FOV: 45 degrees. Color fundus photograph
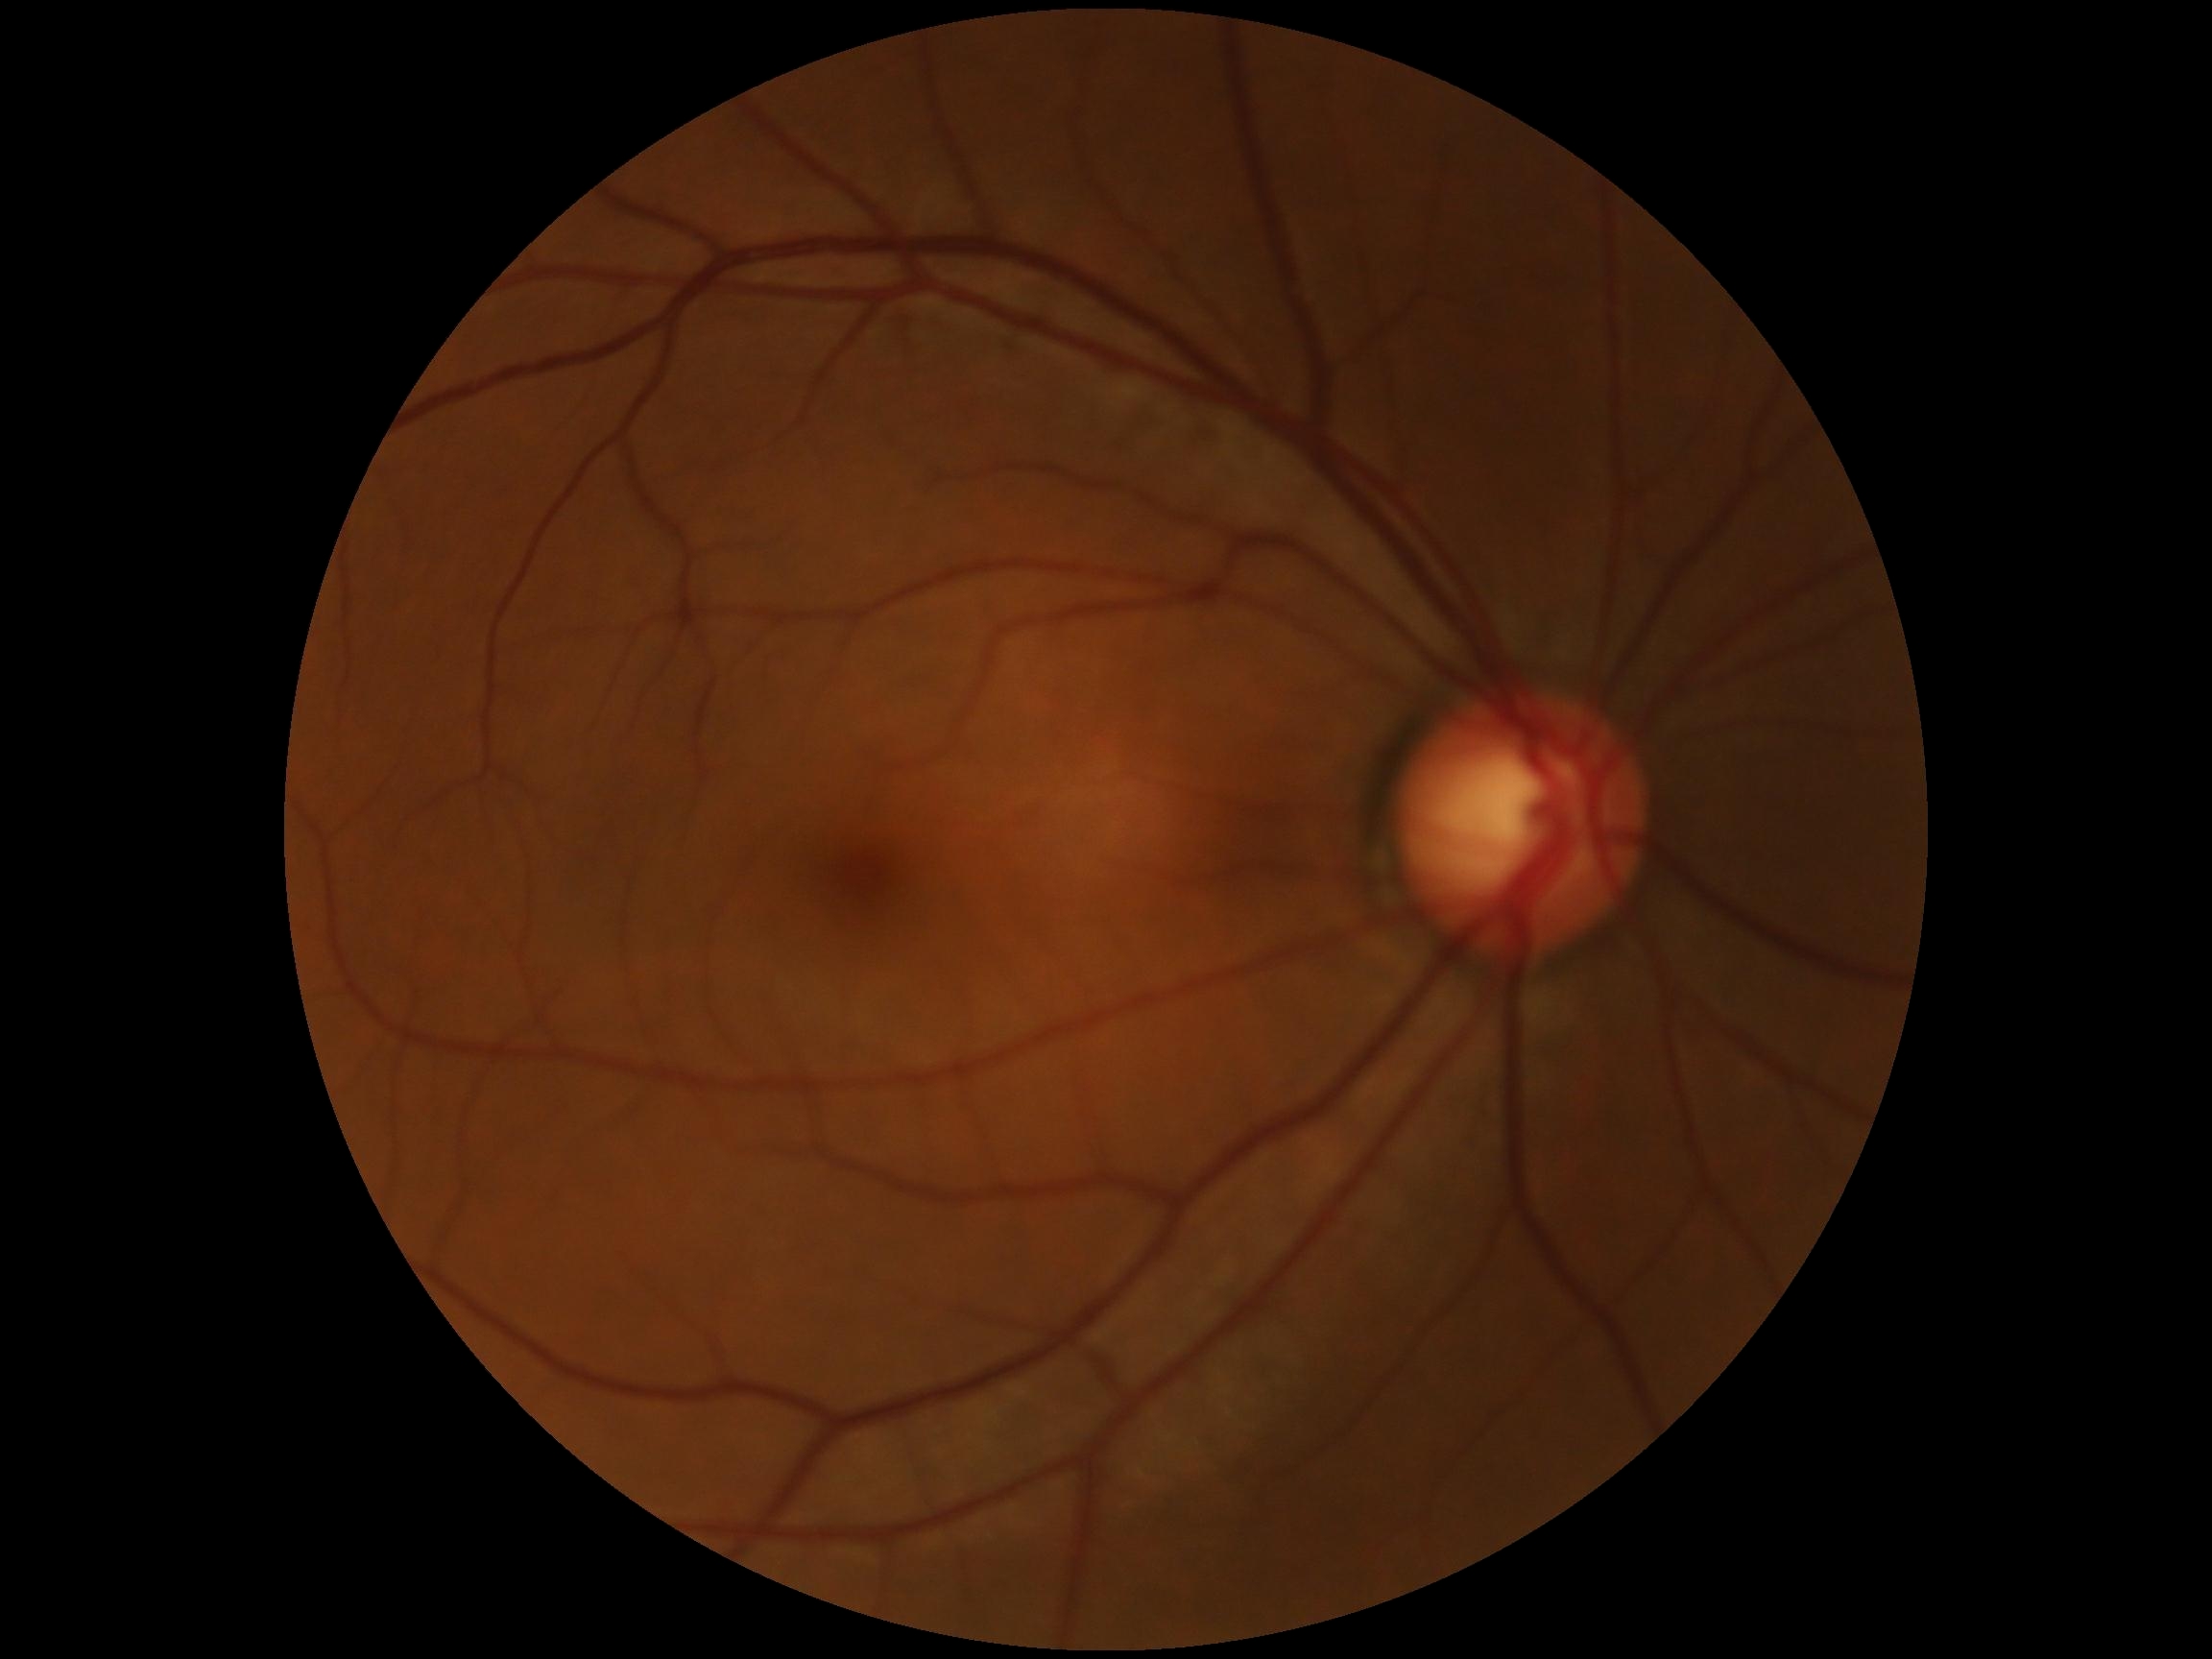

retinopathy: grade 0.